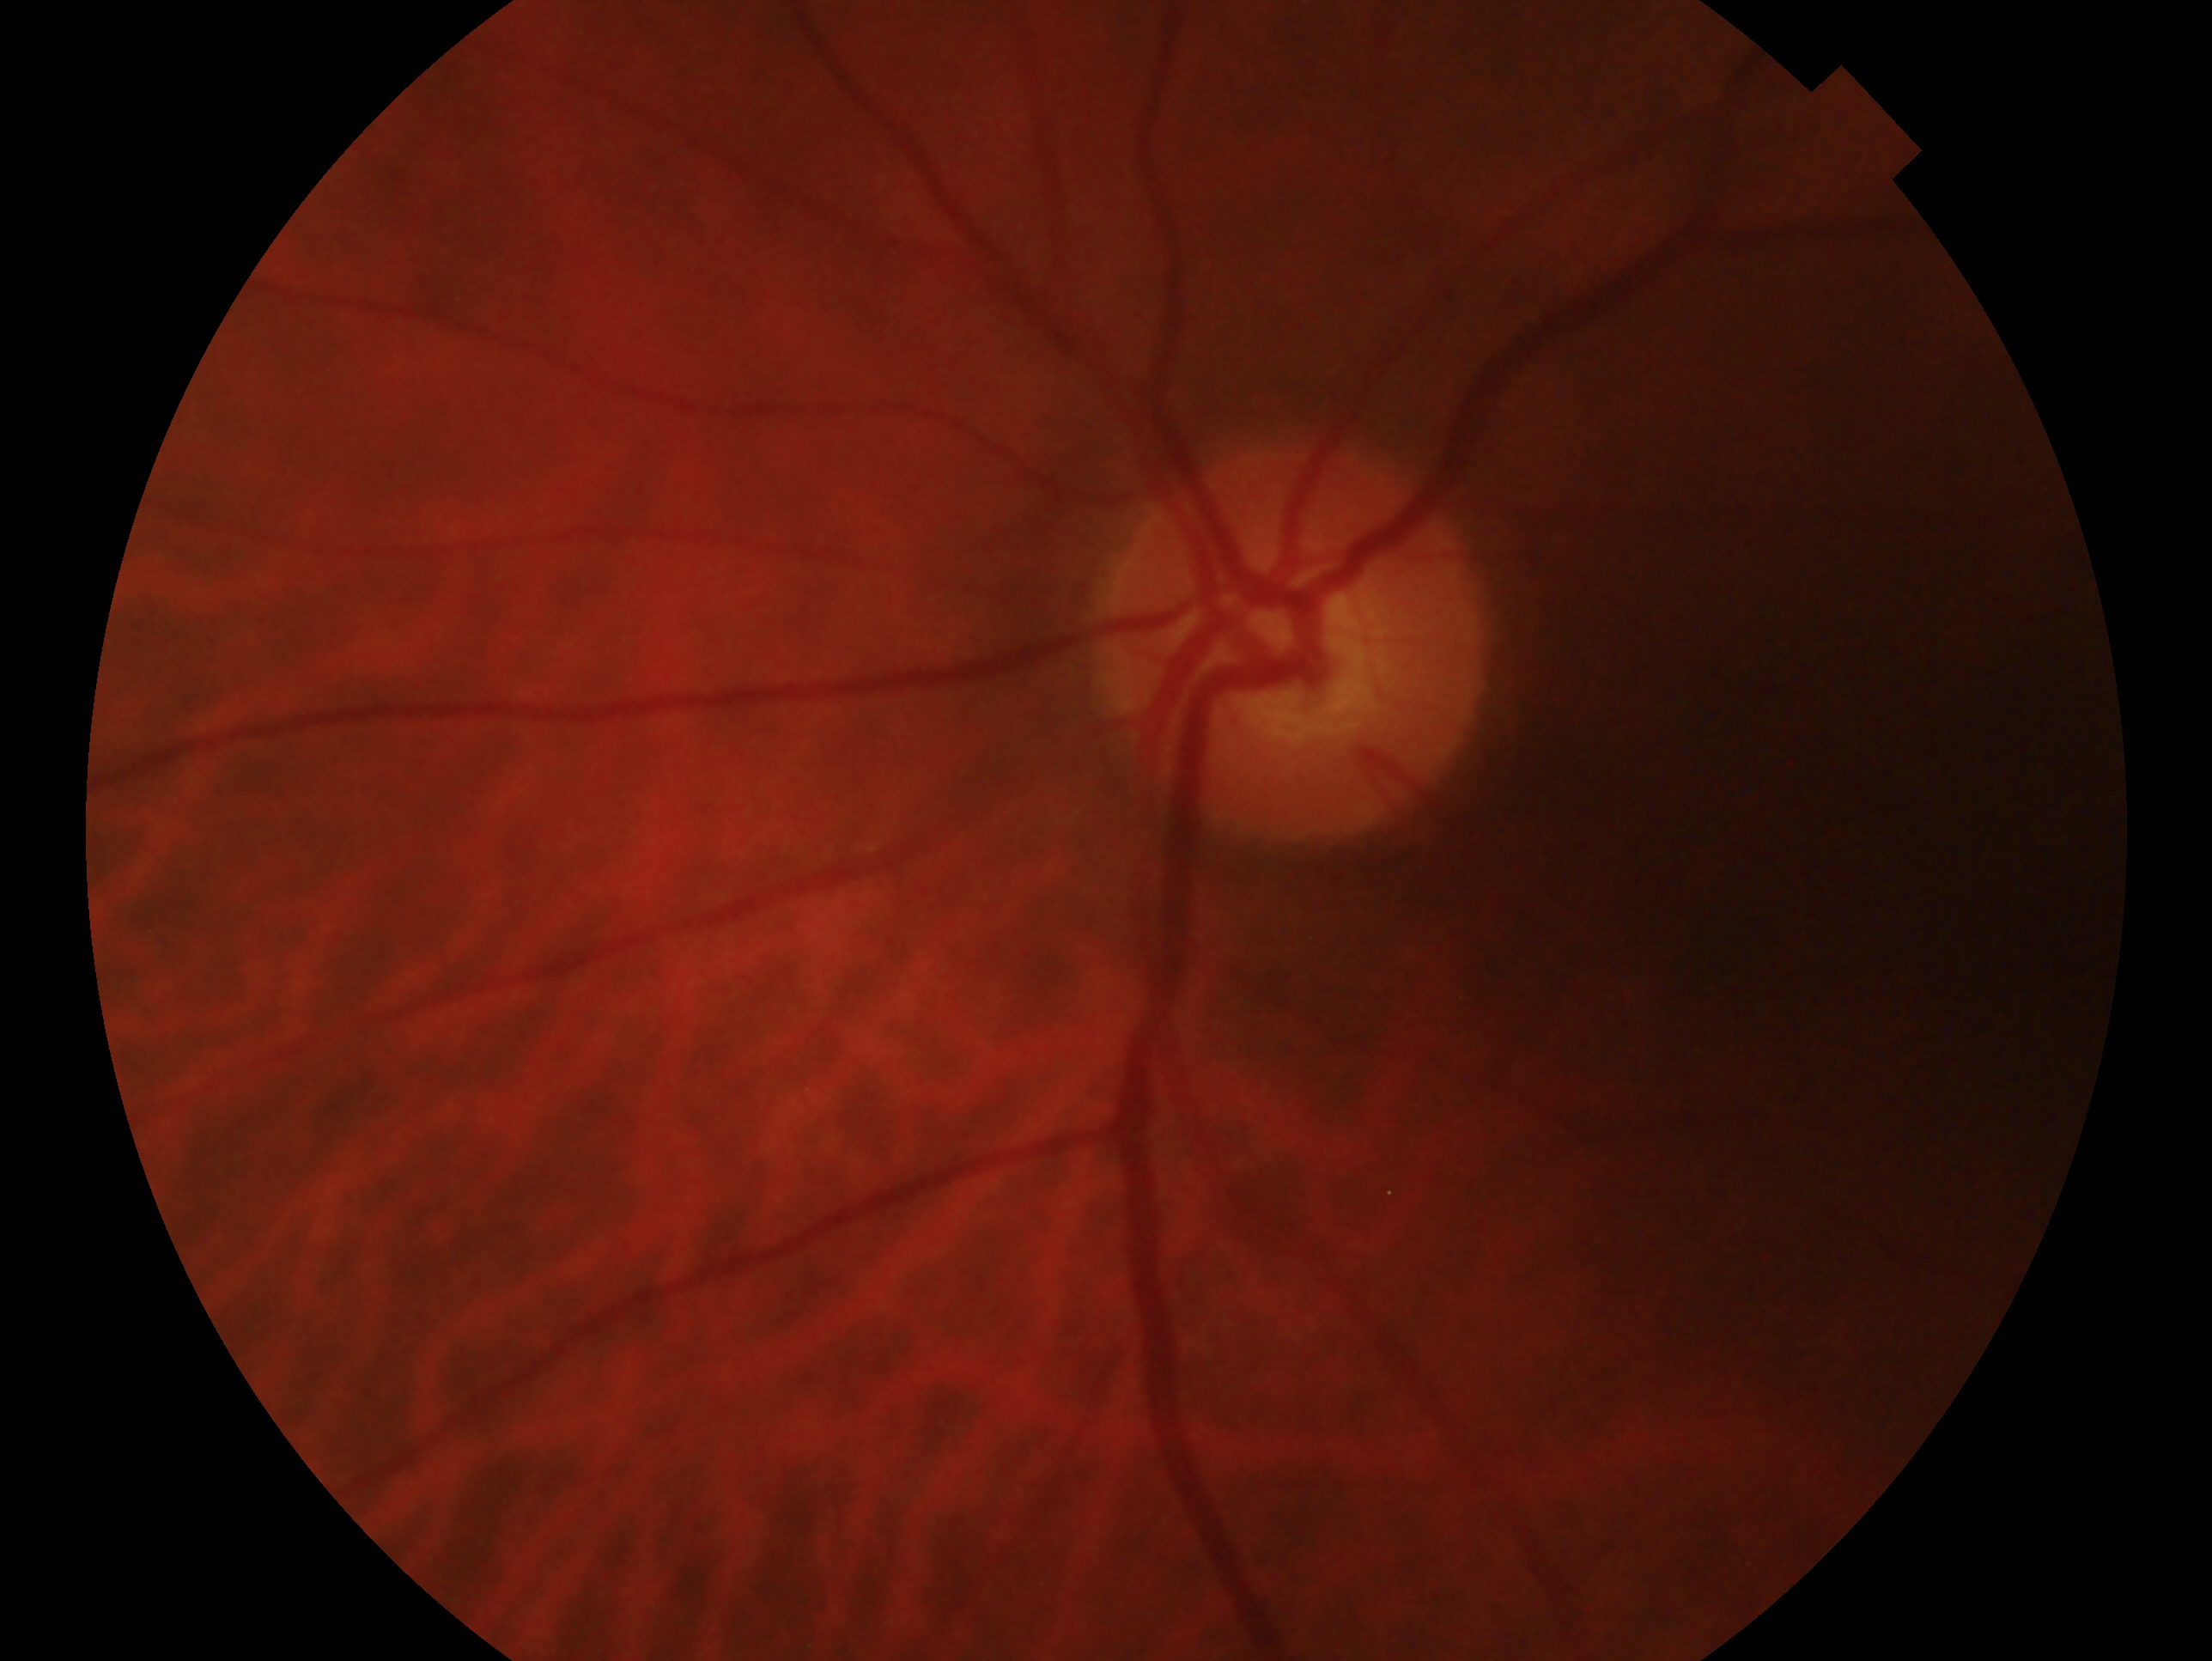 Assessment: no signs of glaucoma — no clinical evidence of glaucoma in this eye.
Imaged eye: left.